Wide-field fundus photograph of an infant:
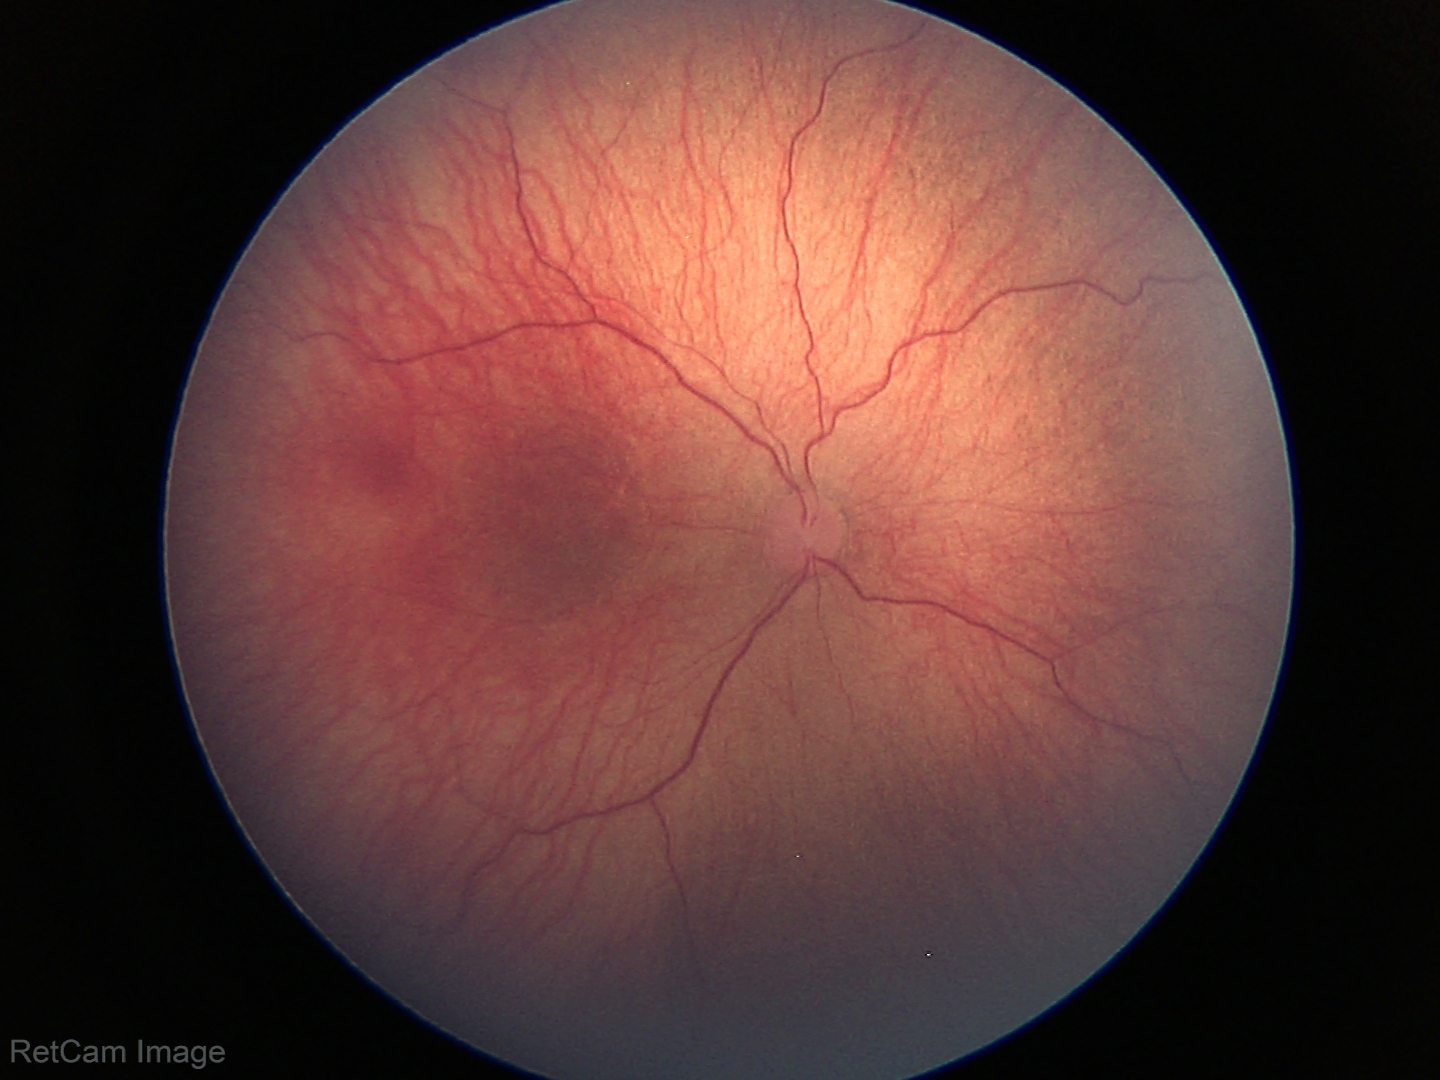

Screening series with retinopathy of prematurity stage 1. Without plus disease.